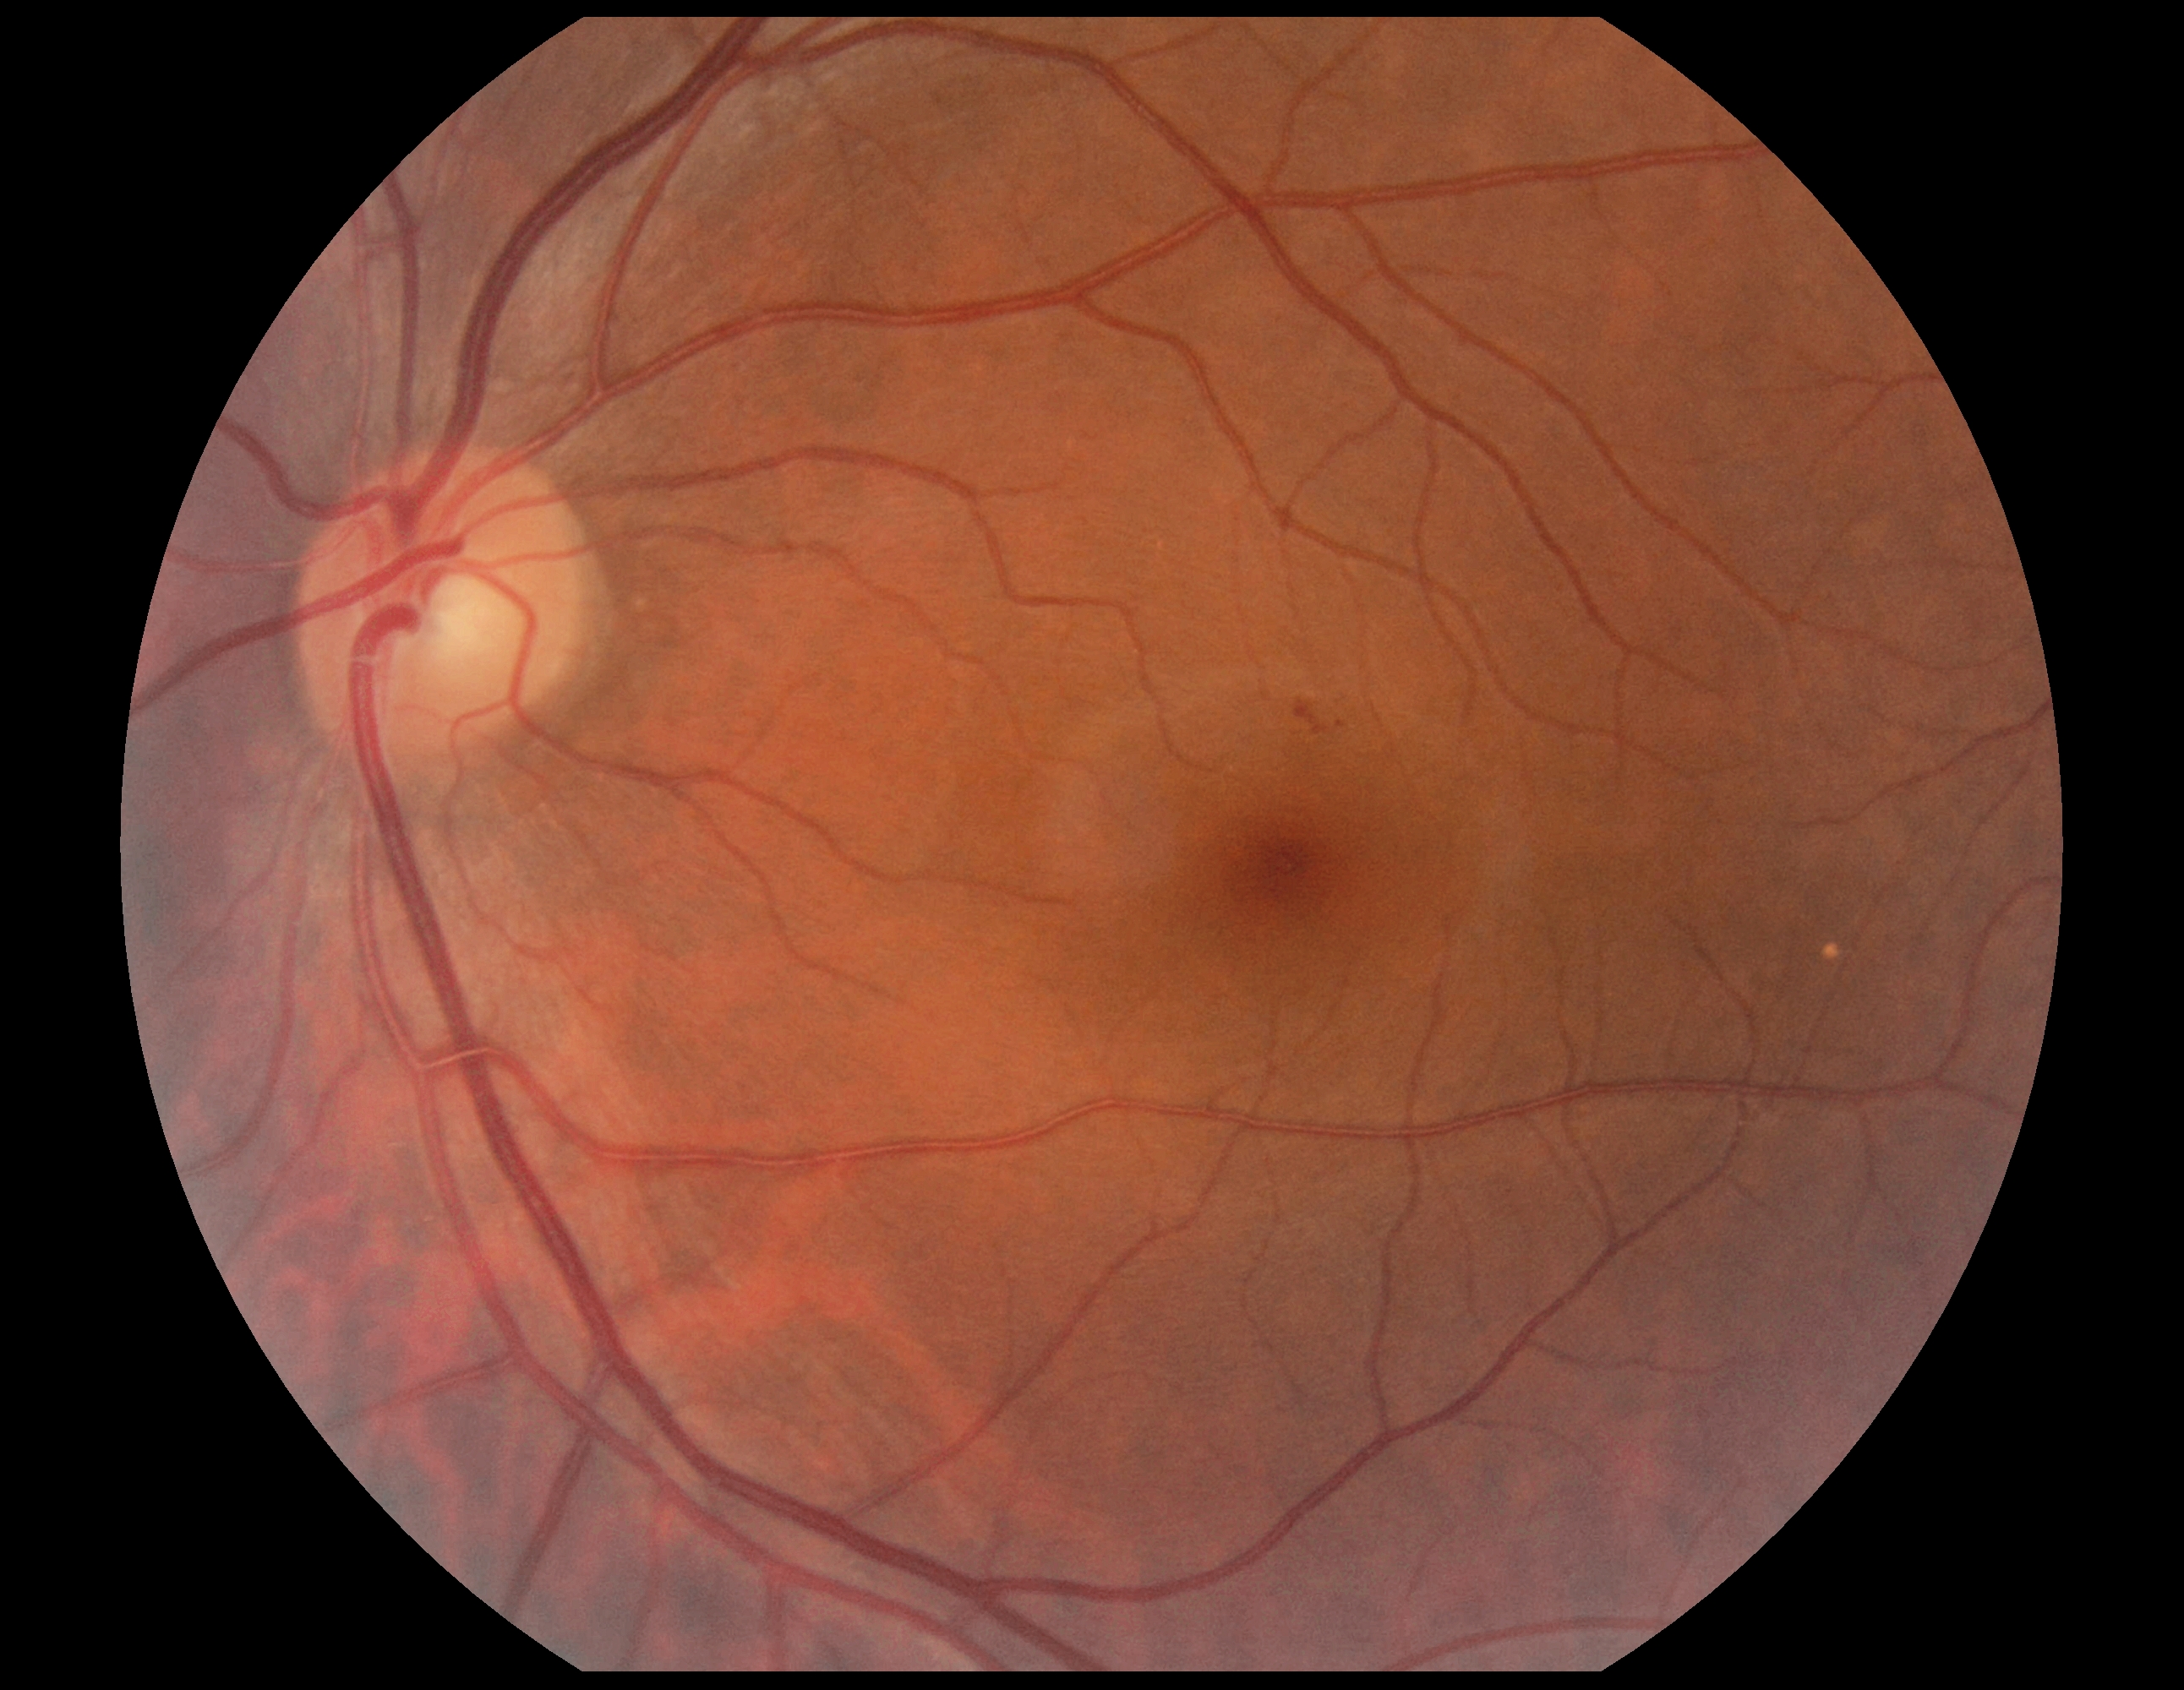

{"dr_grade": "2"}